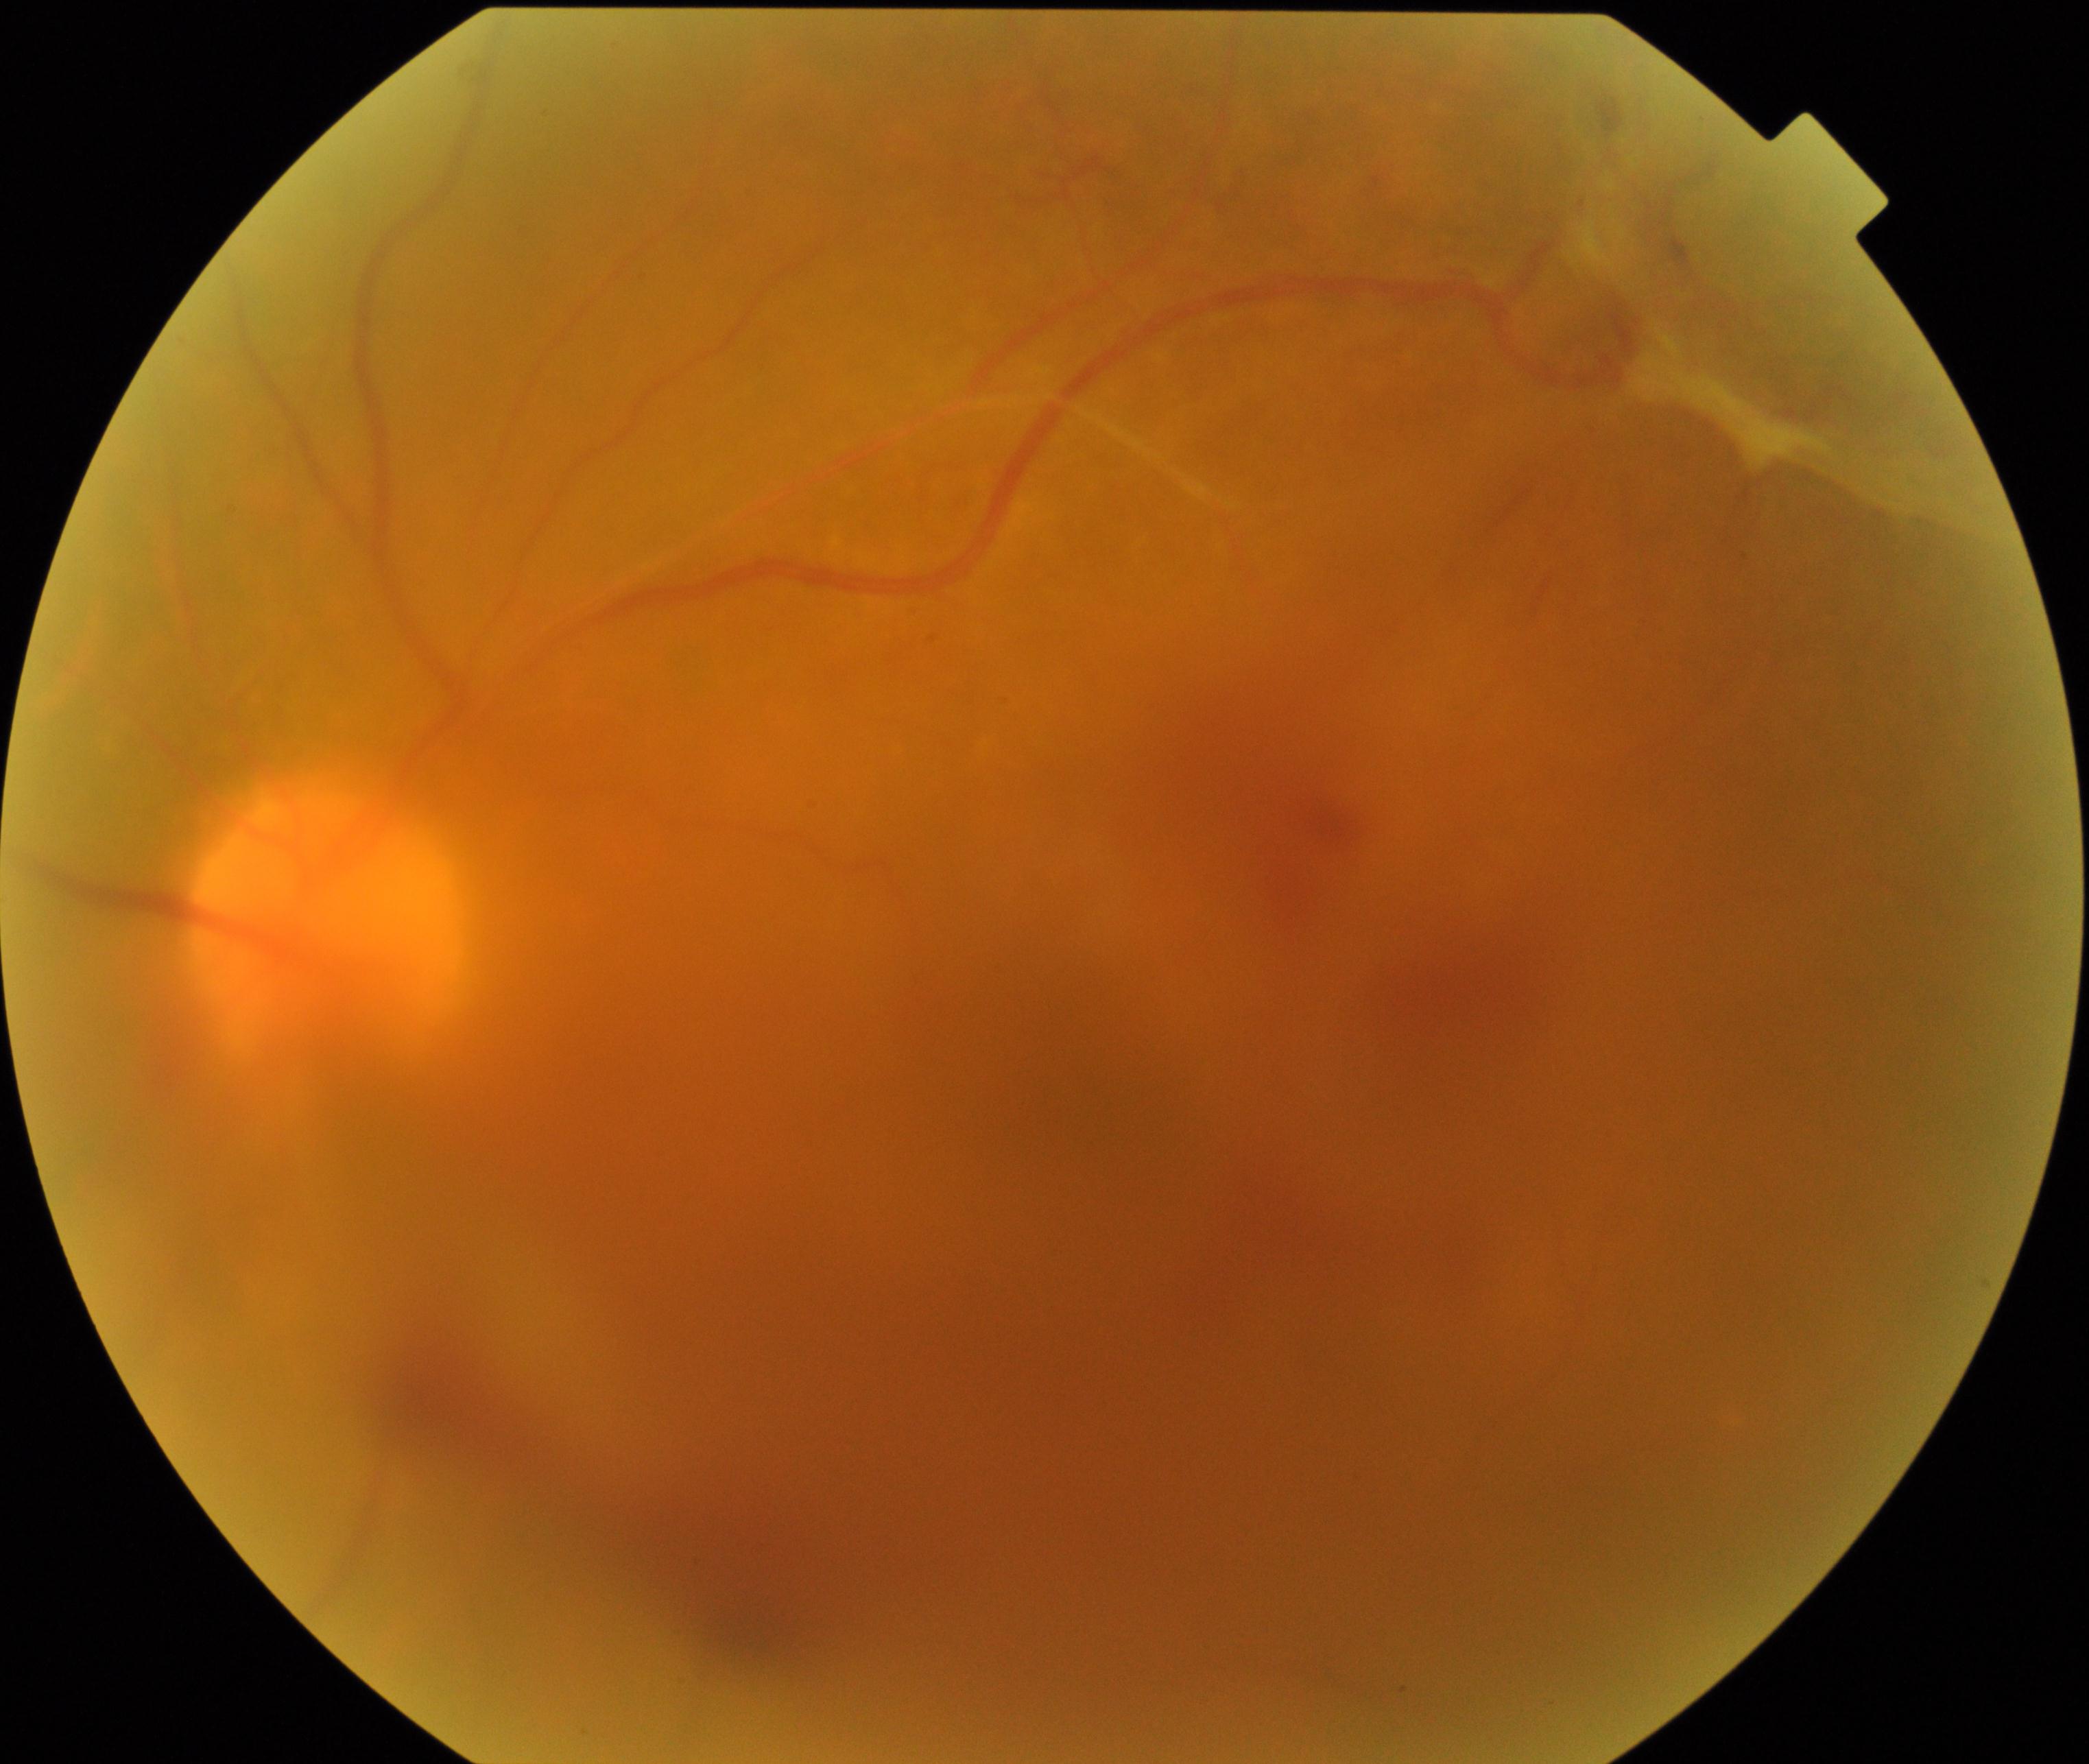

Quality: significantly degraded. Proliferative retinopathy: suspected, not confirmed.